Color fundus image.
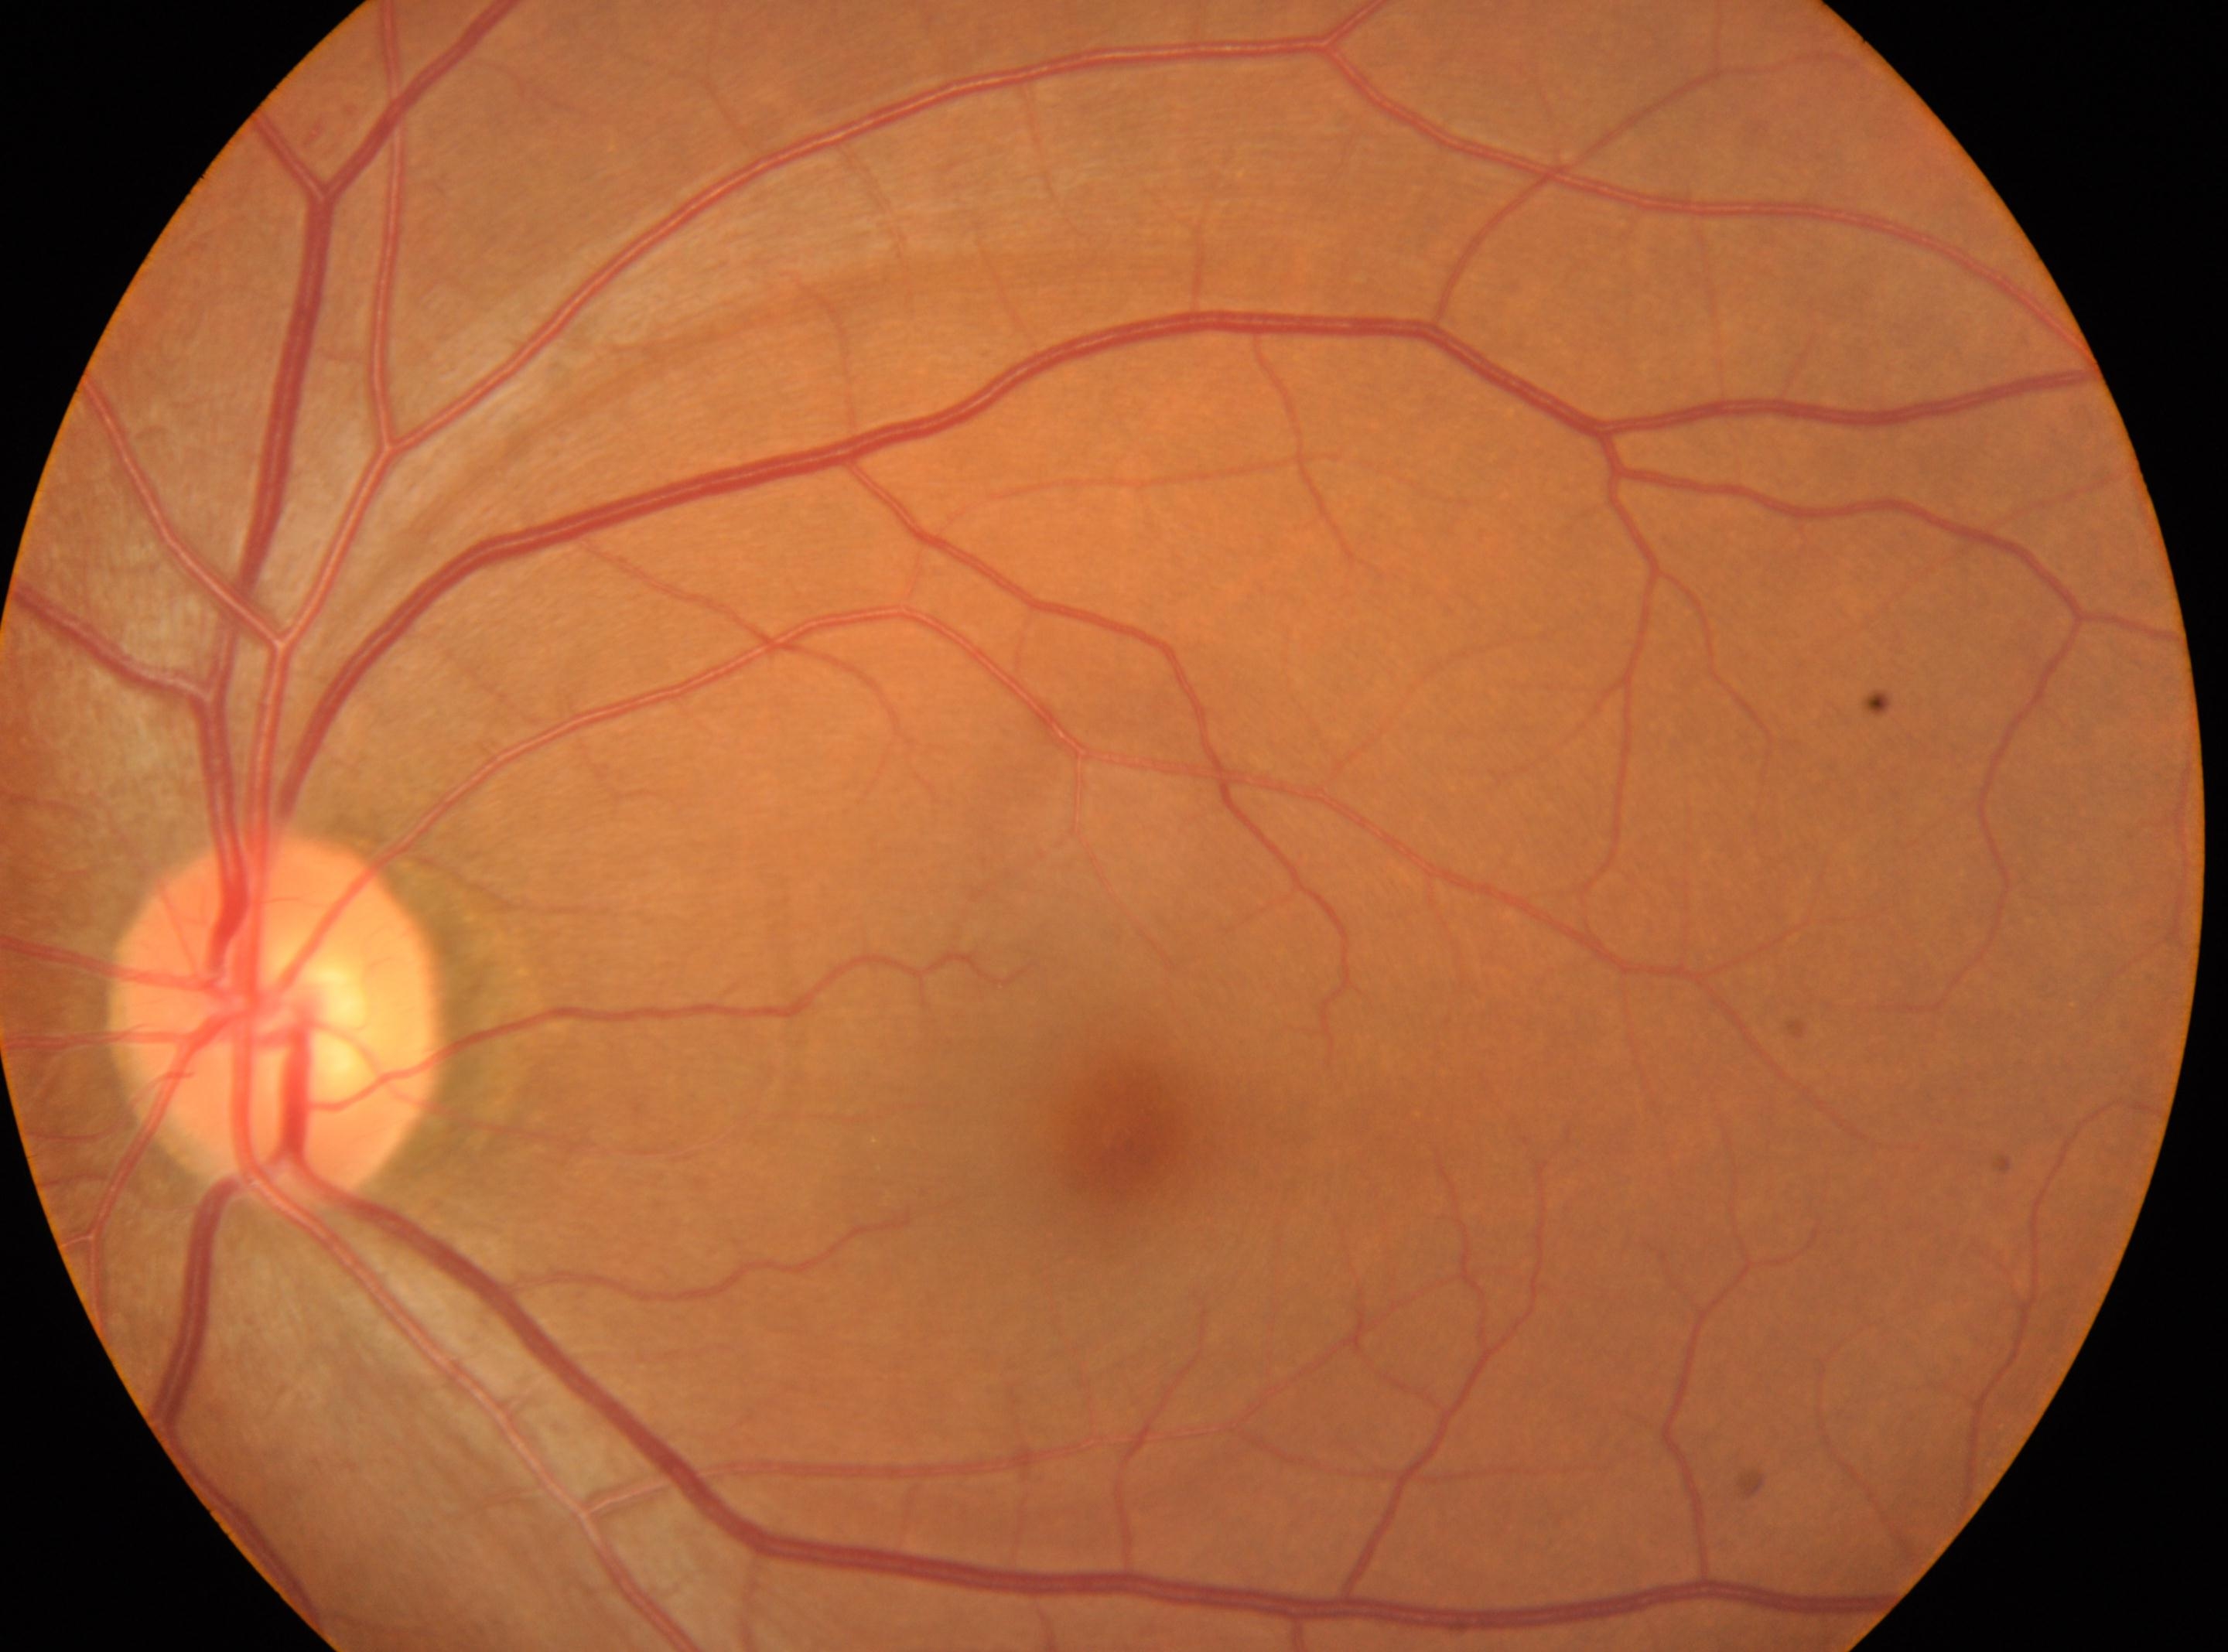
Imaged eye: left eye. DR grade is no apparent retinopathy (0). Optic disc: (x=275, y=1018). Foveal center located at (x=1119, y=1135).